1659x2212px; color fundus photograph.
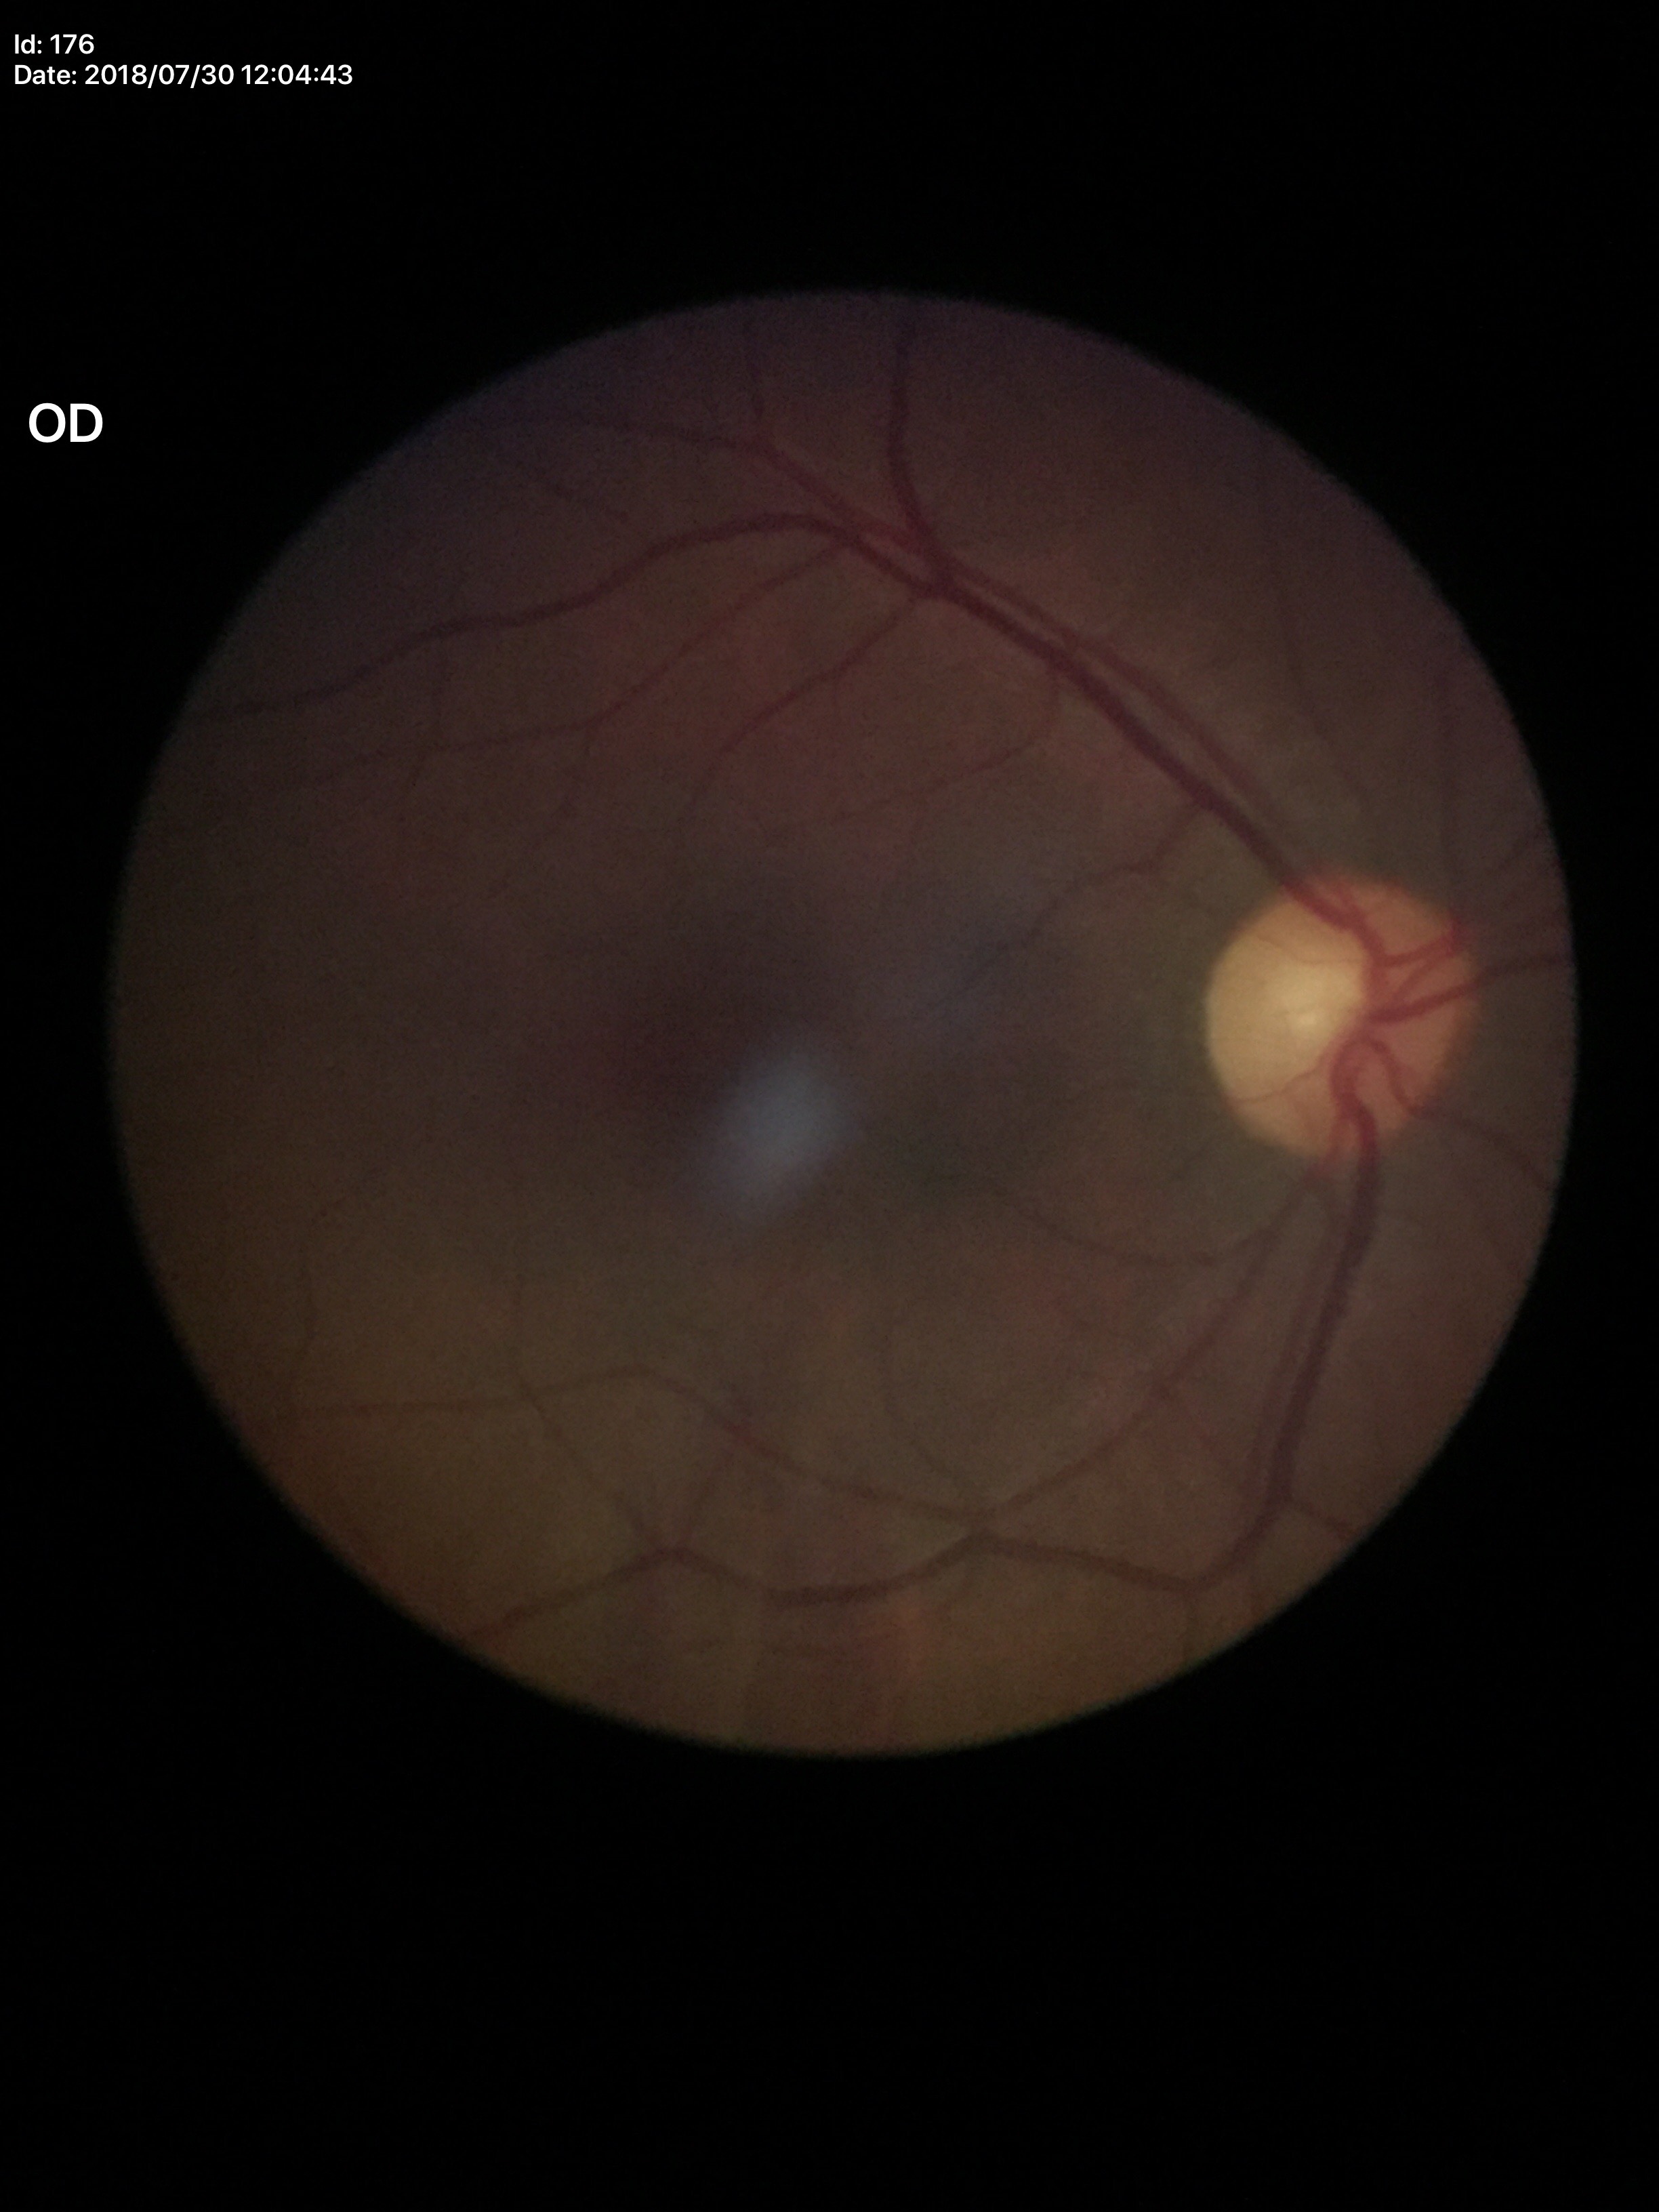

horizontal cup-to-disc ratio (HCDR) = 0.52, Glaucoma decision = negative (1/5 graders called glaucoma suspect), vertical CDR (VCDR) = 0.55.